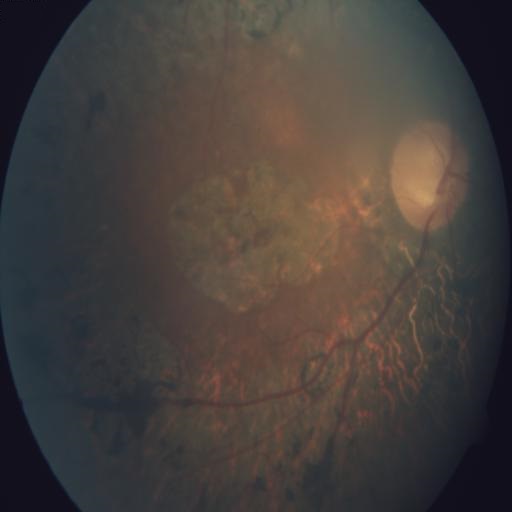 Impression: macular scar (MS).